IOP 20 mmHg; corneal thickness: 589 µm; non-mydriatic; FOV: 30 degrees; 82-year-old patient; 2212 by 1661 pixels; refractive error: +0.25 -0.75 x 101; axial length (AL): 21.63 mm
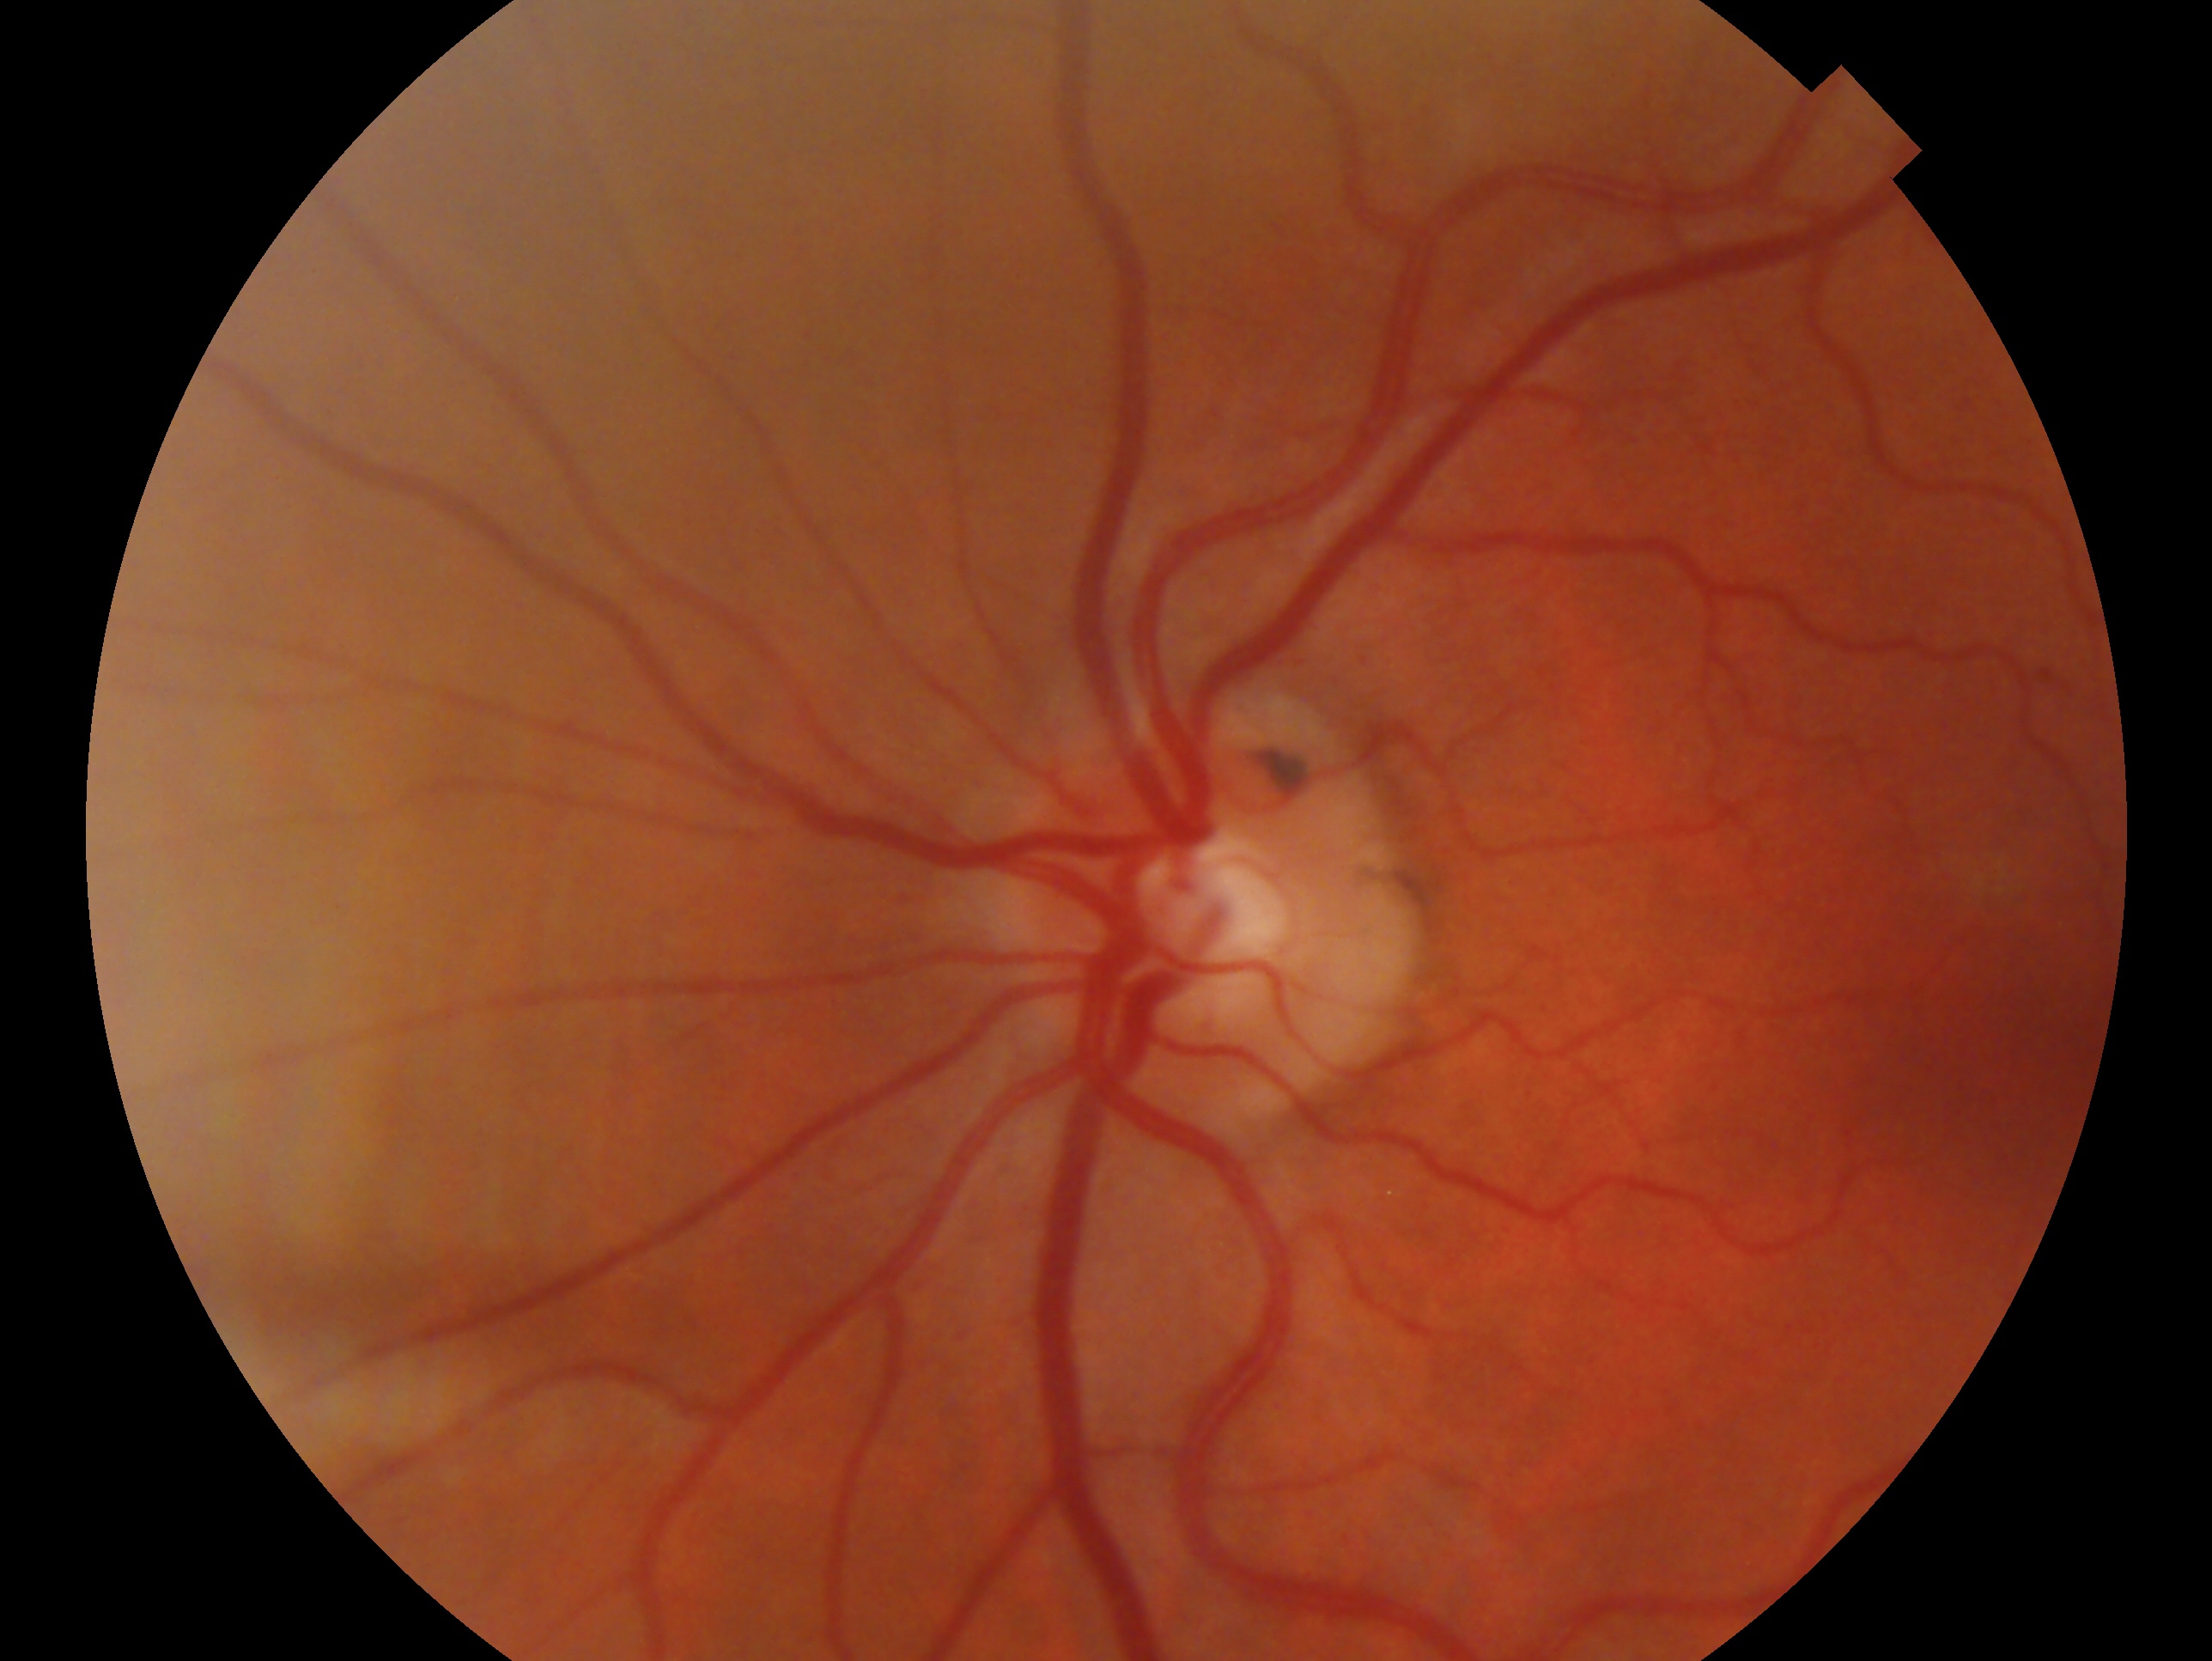 diagnosis=no glaucoma; eye=OS.